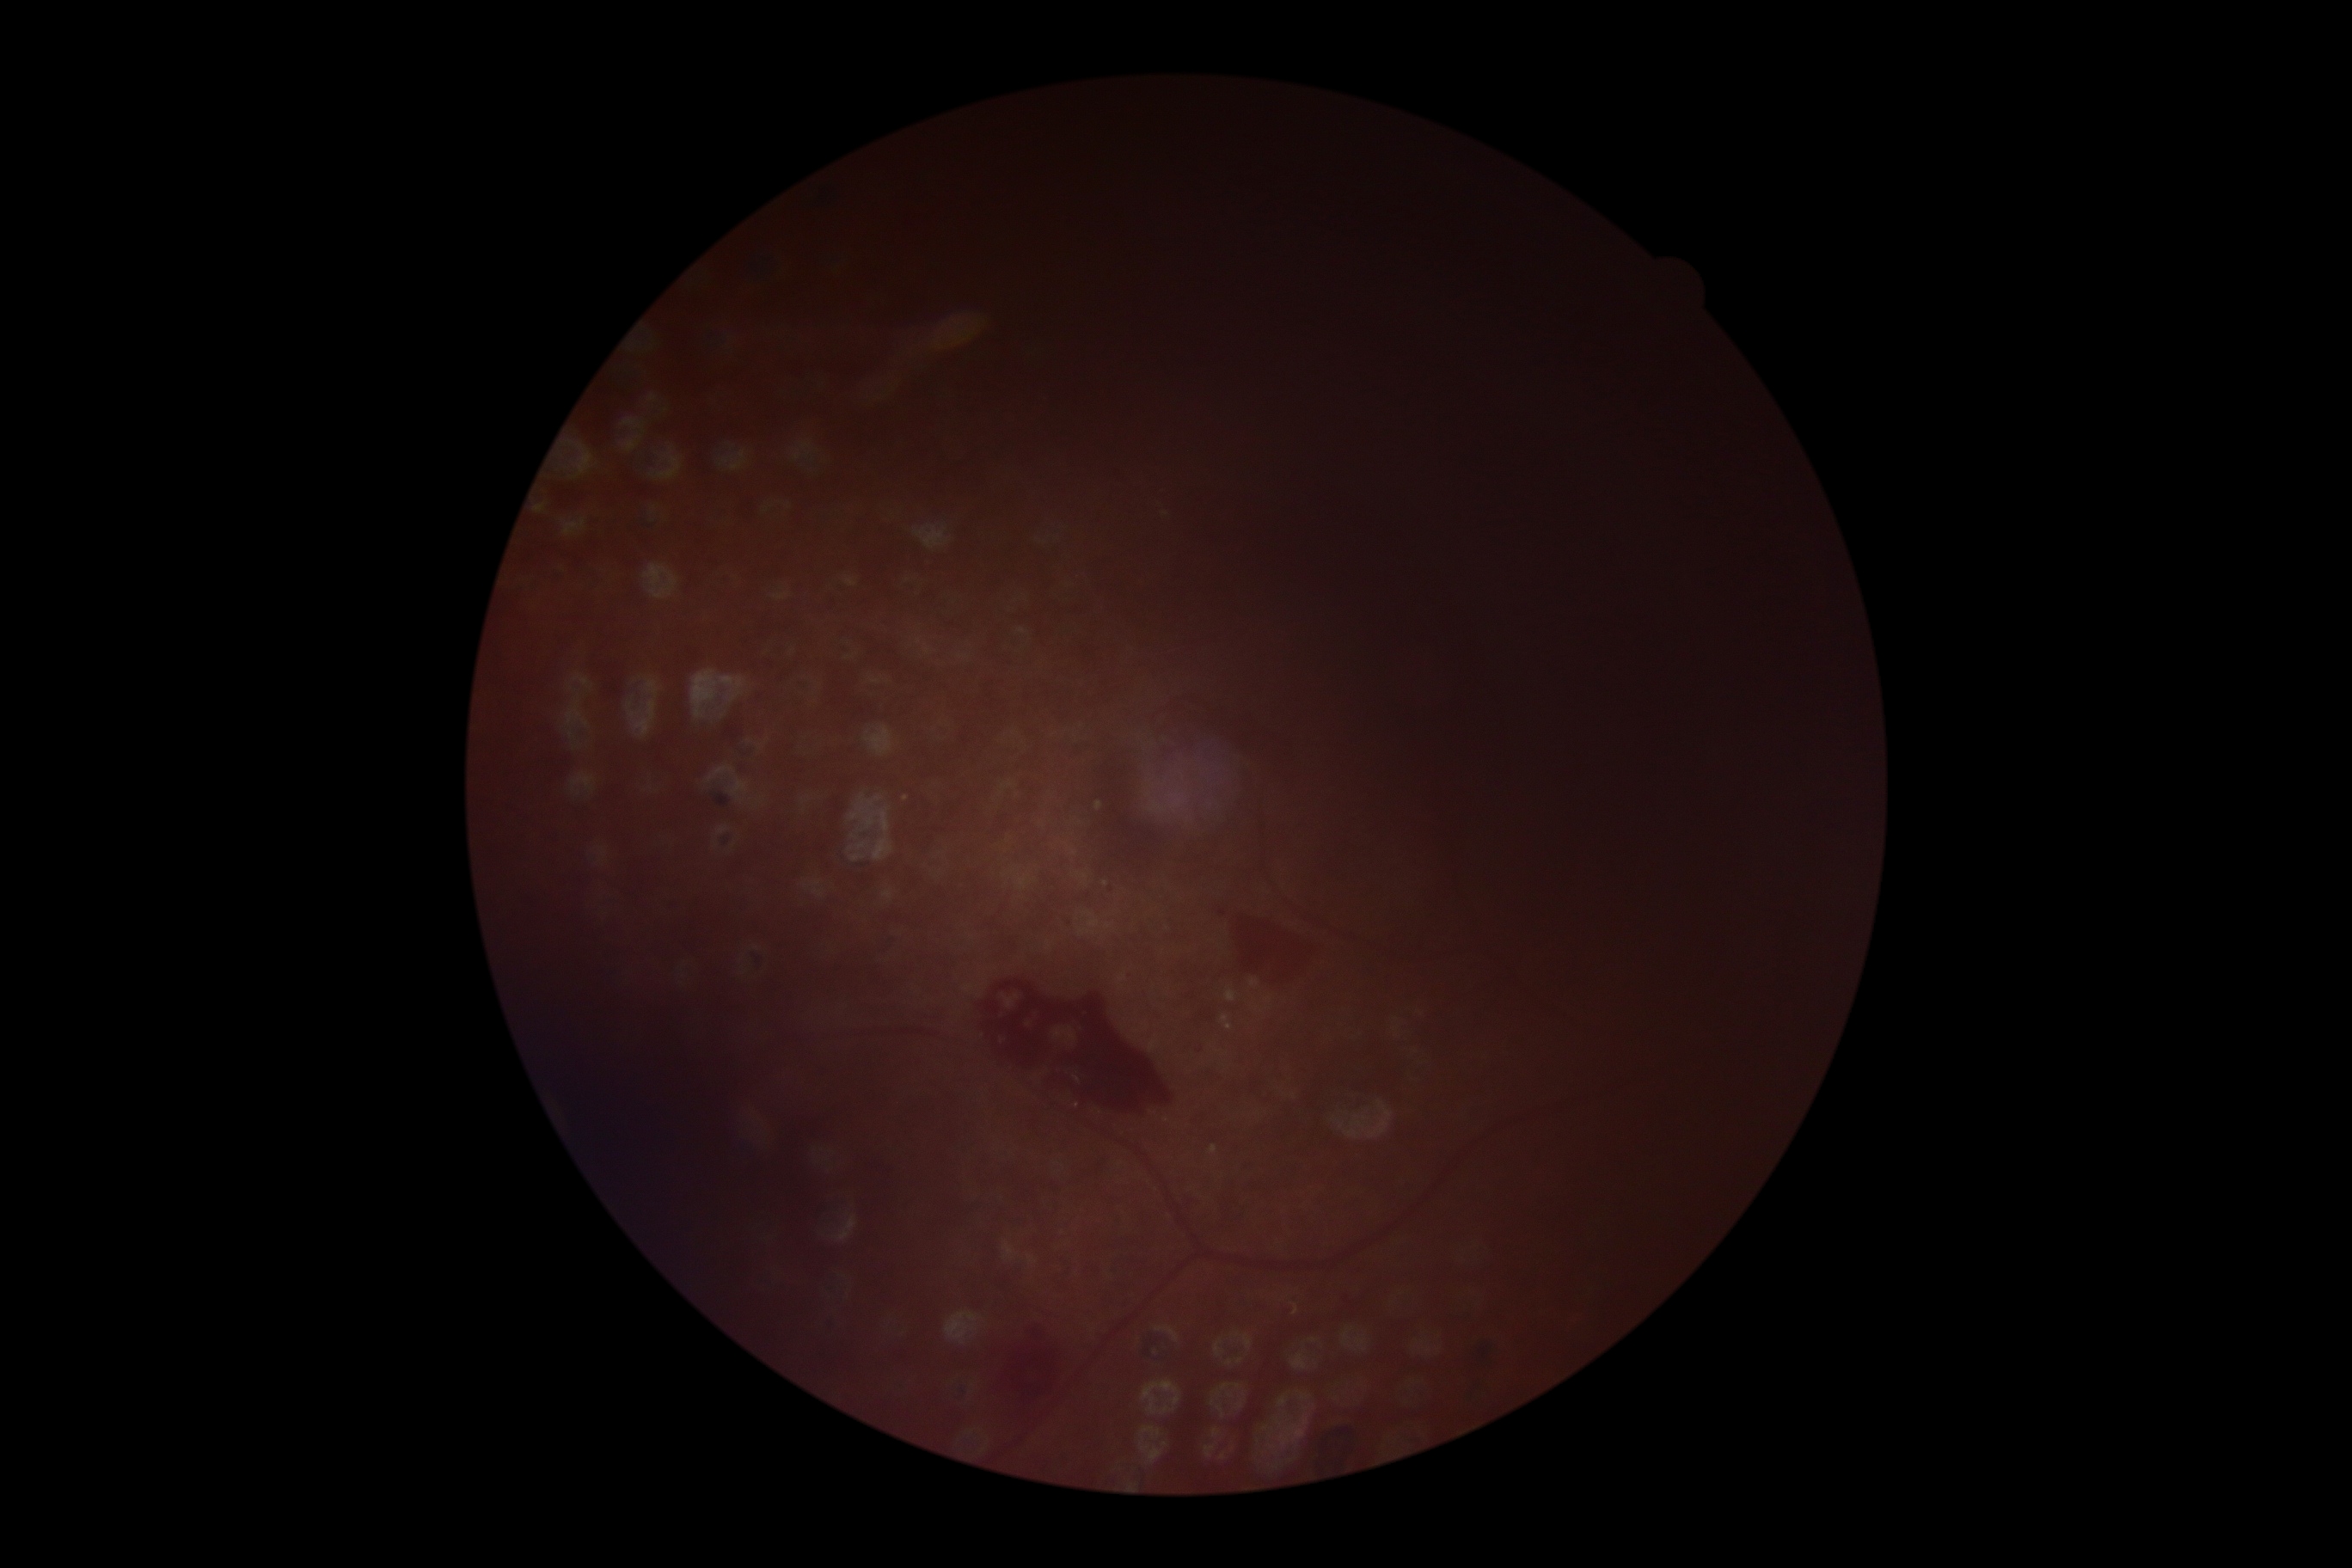

{
  "dr_grade": "grade 4 (PDR)"
}